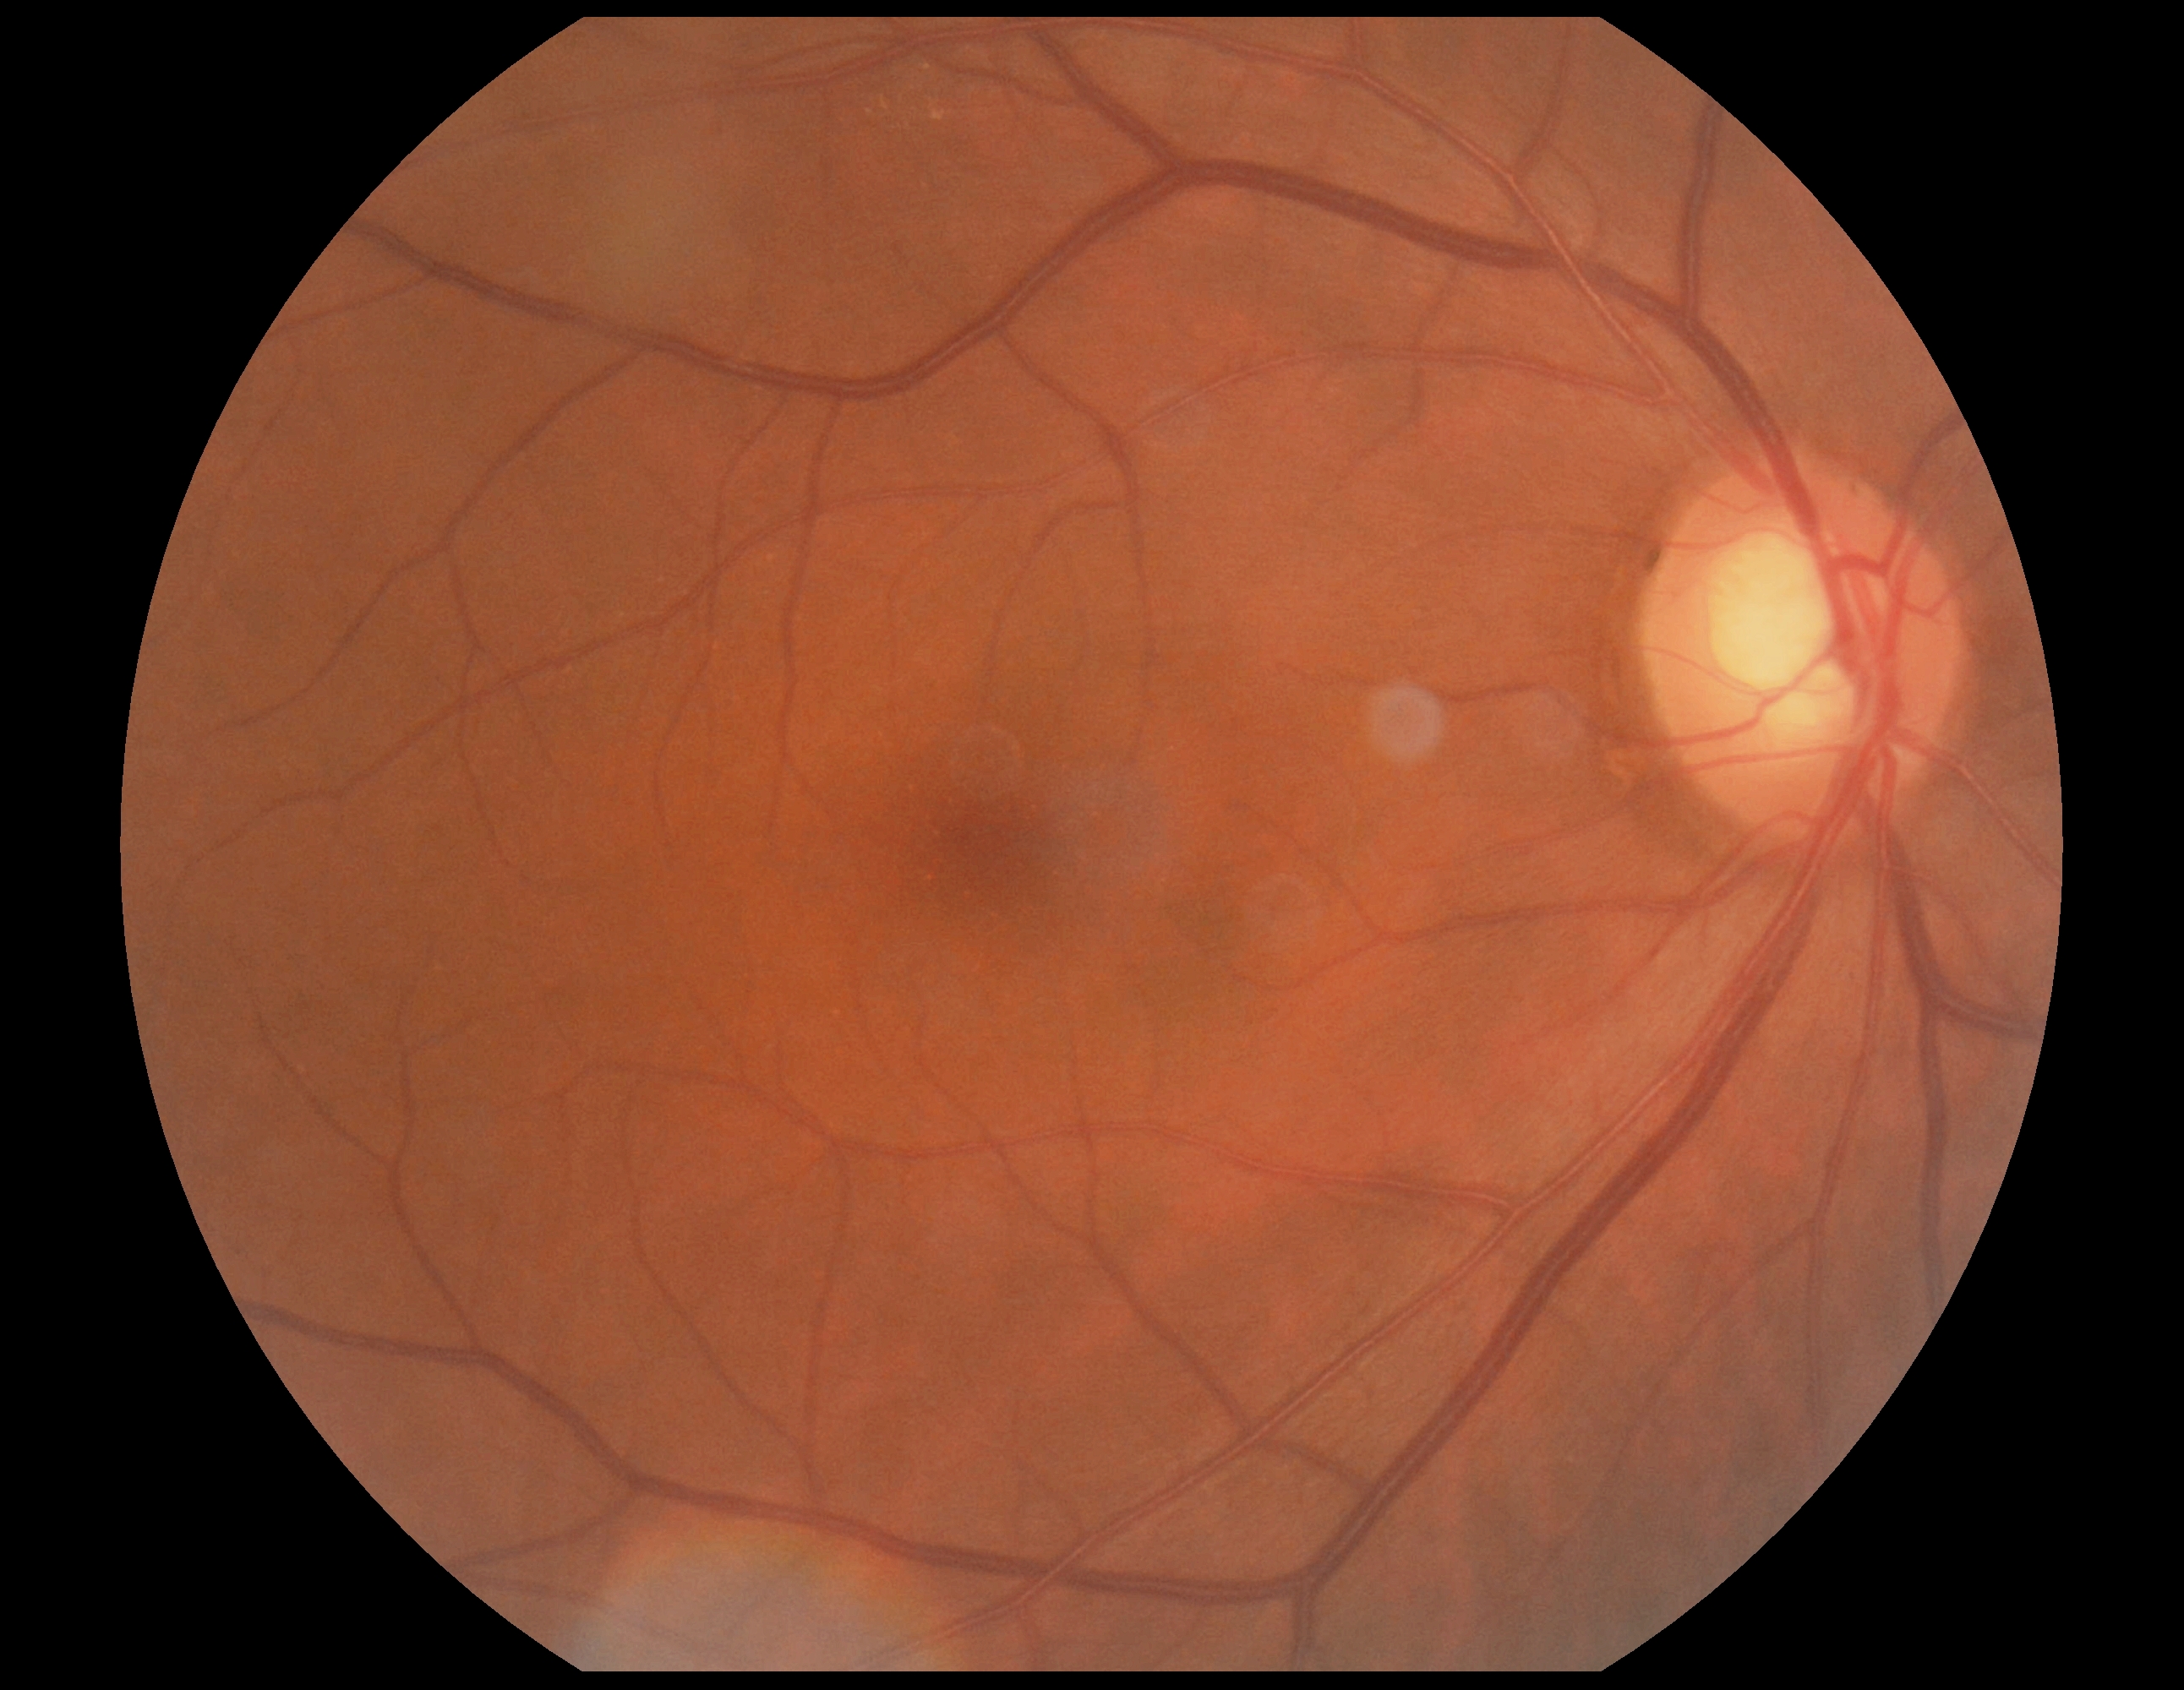 dr_grade: 0/4